Pediatric retinal photograph (wide-field). Camera: Phoenix ICON (100° FOV).
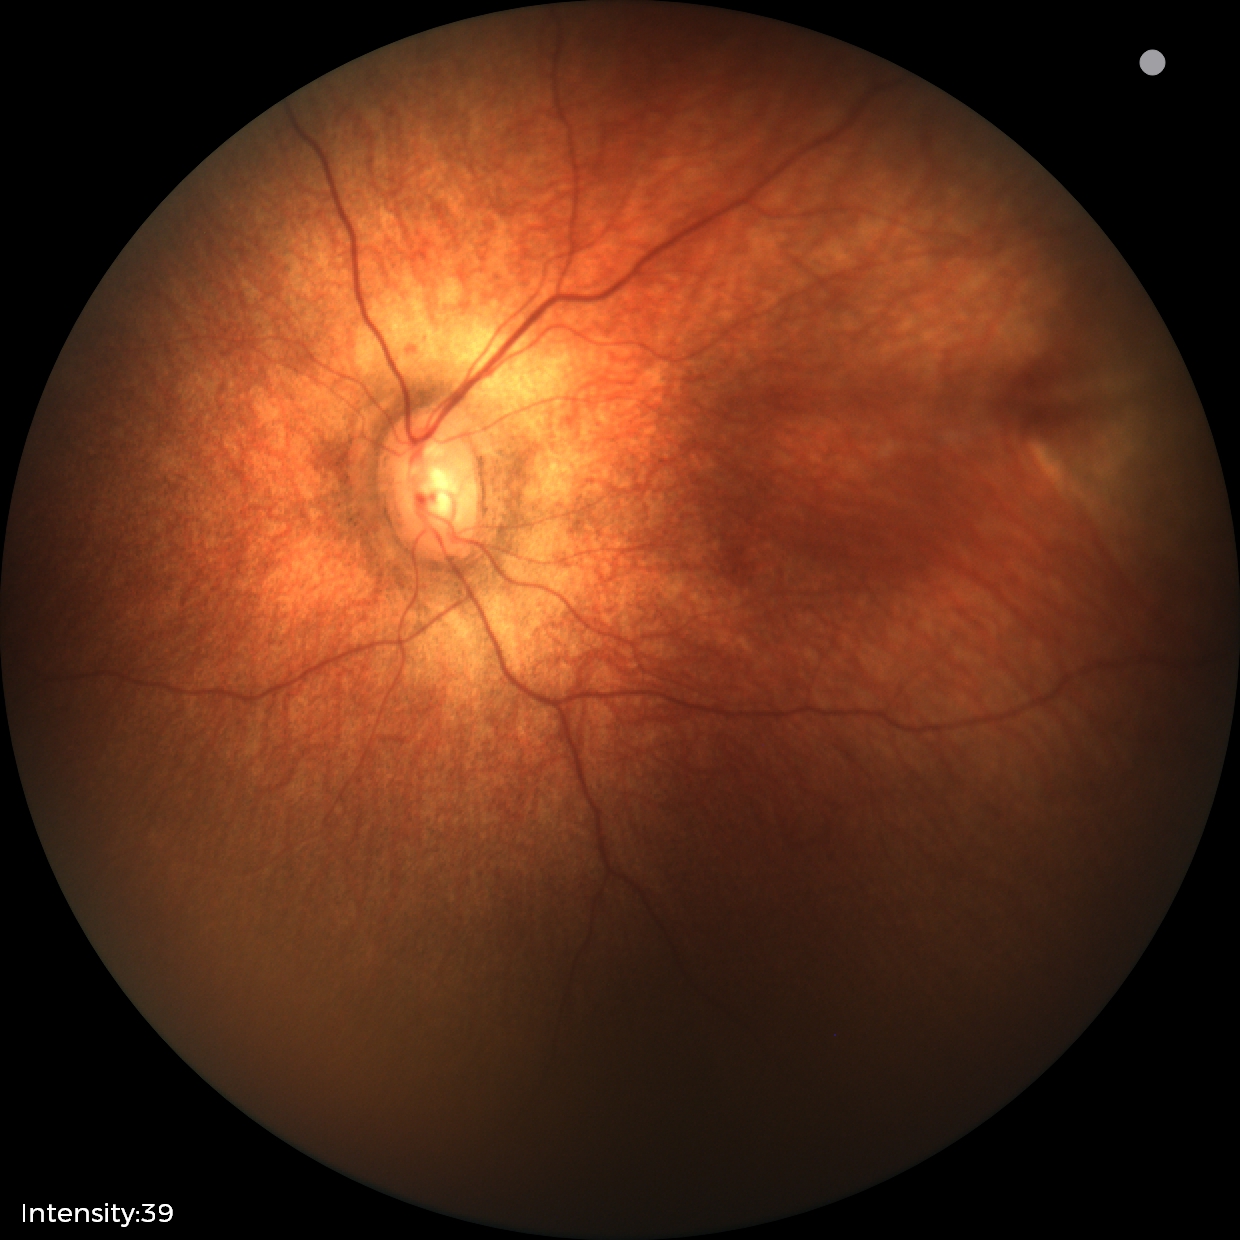 Finding = physiological appearance.